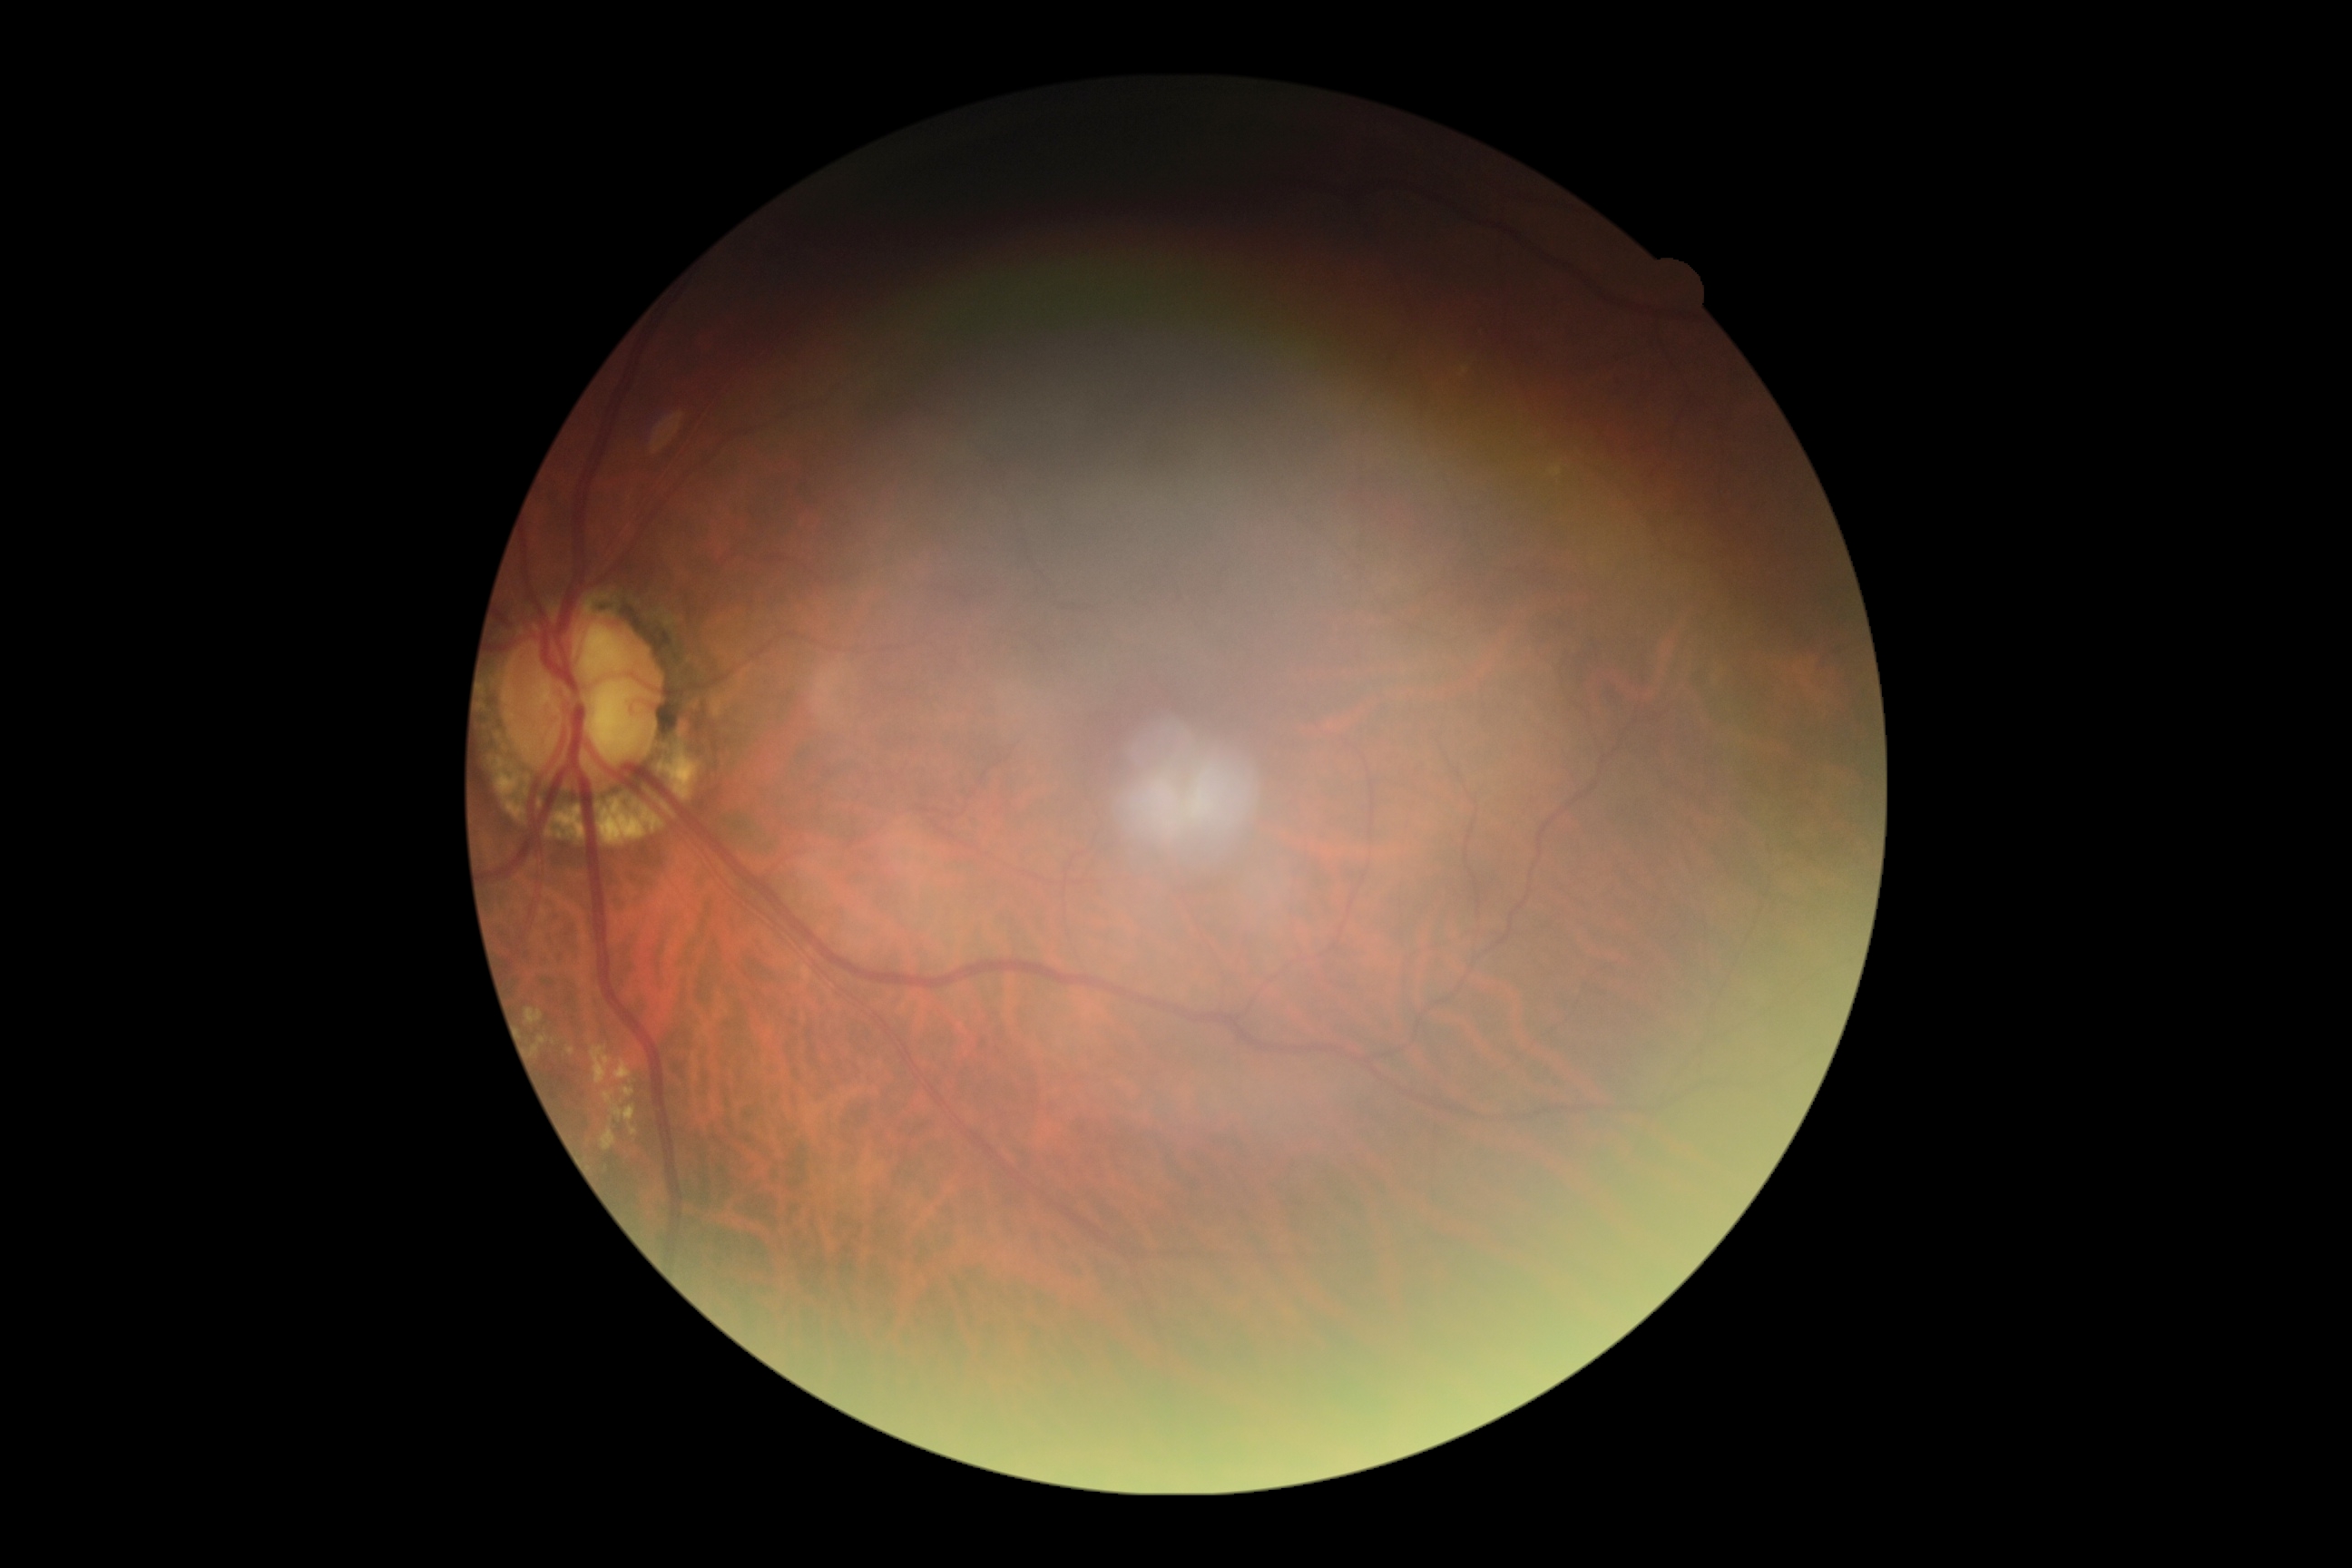 DR severity = grade 2 (moderate NPDR).